Posterior pole color fundus photograph, image size 848x848, modified Davis classification, NIDEK AFC-230: 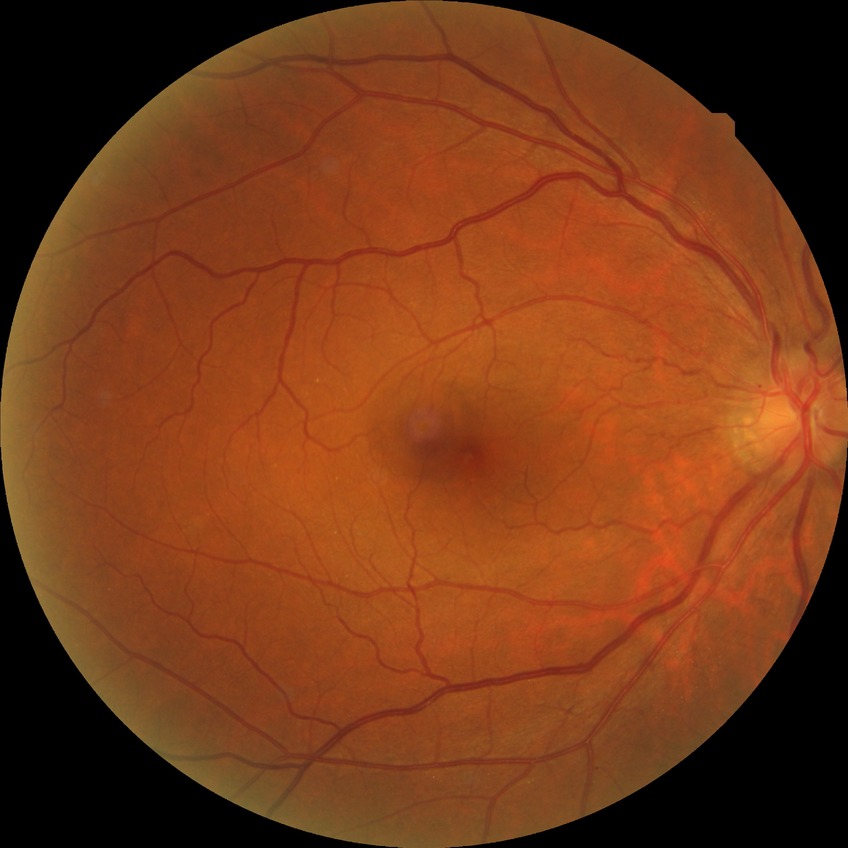
{"davis_grade": "simple diabetic retinopathy"}